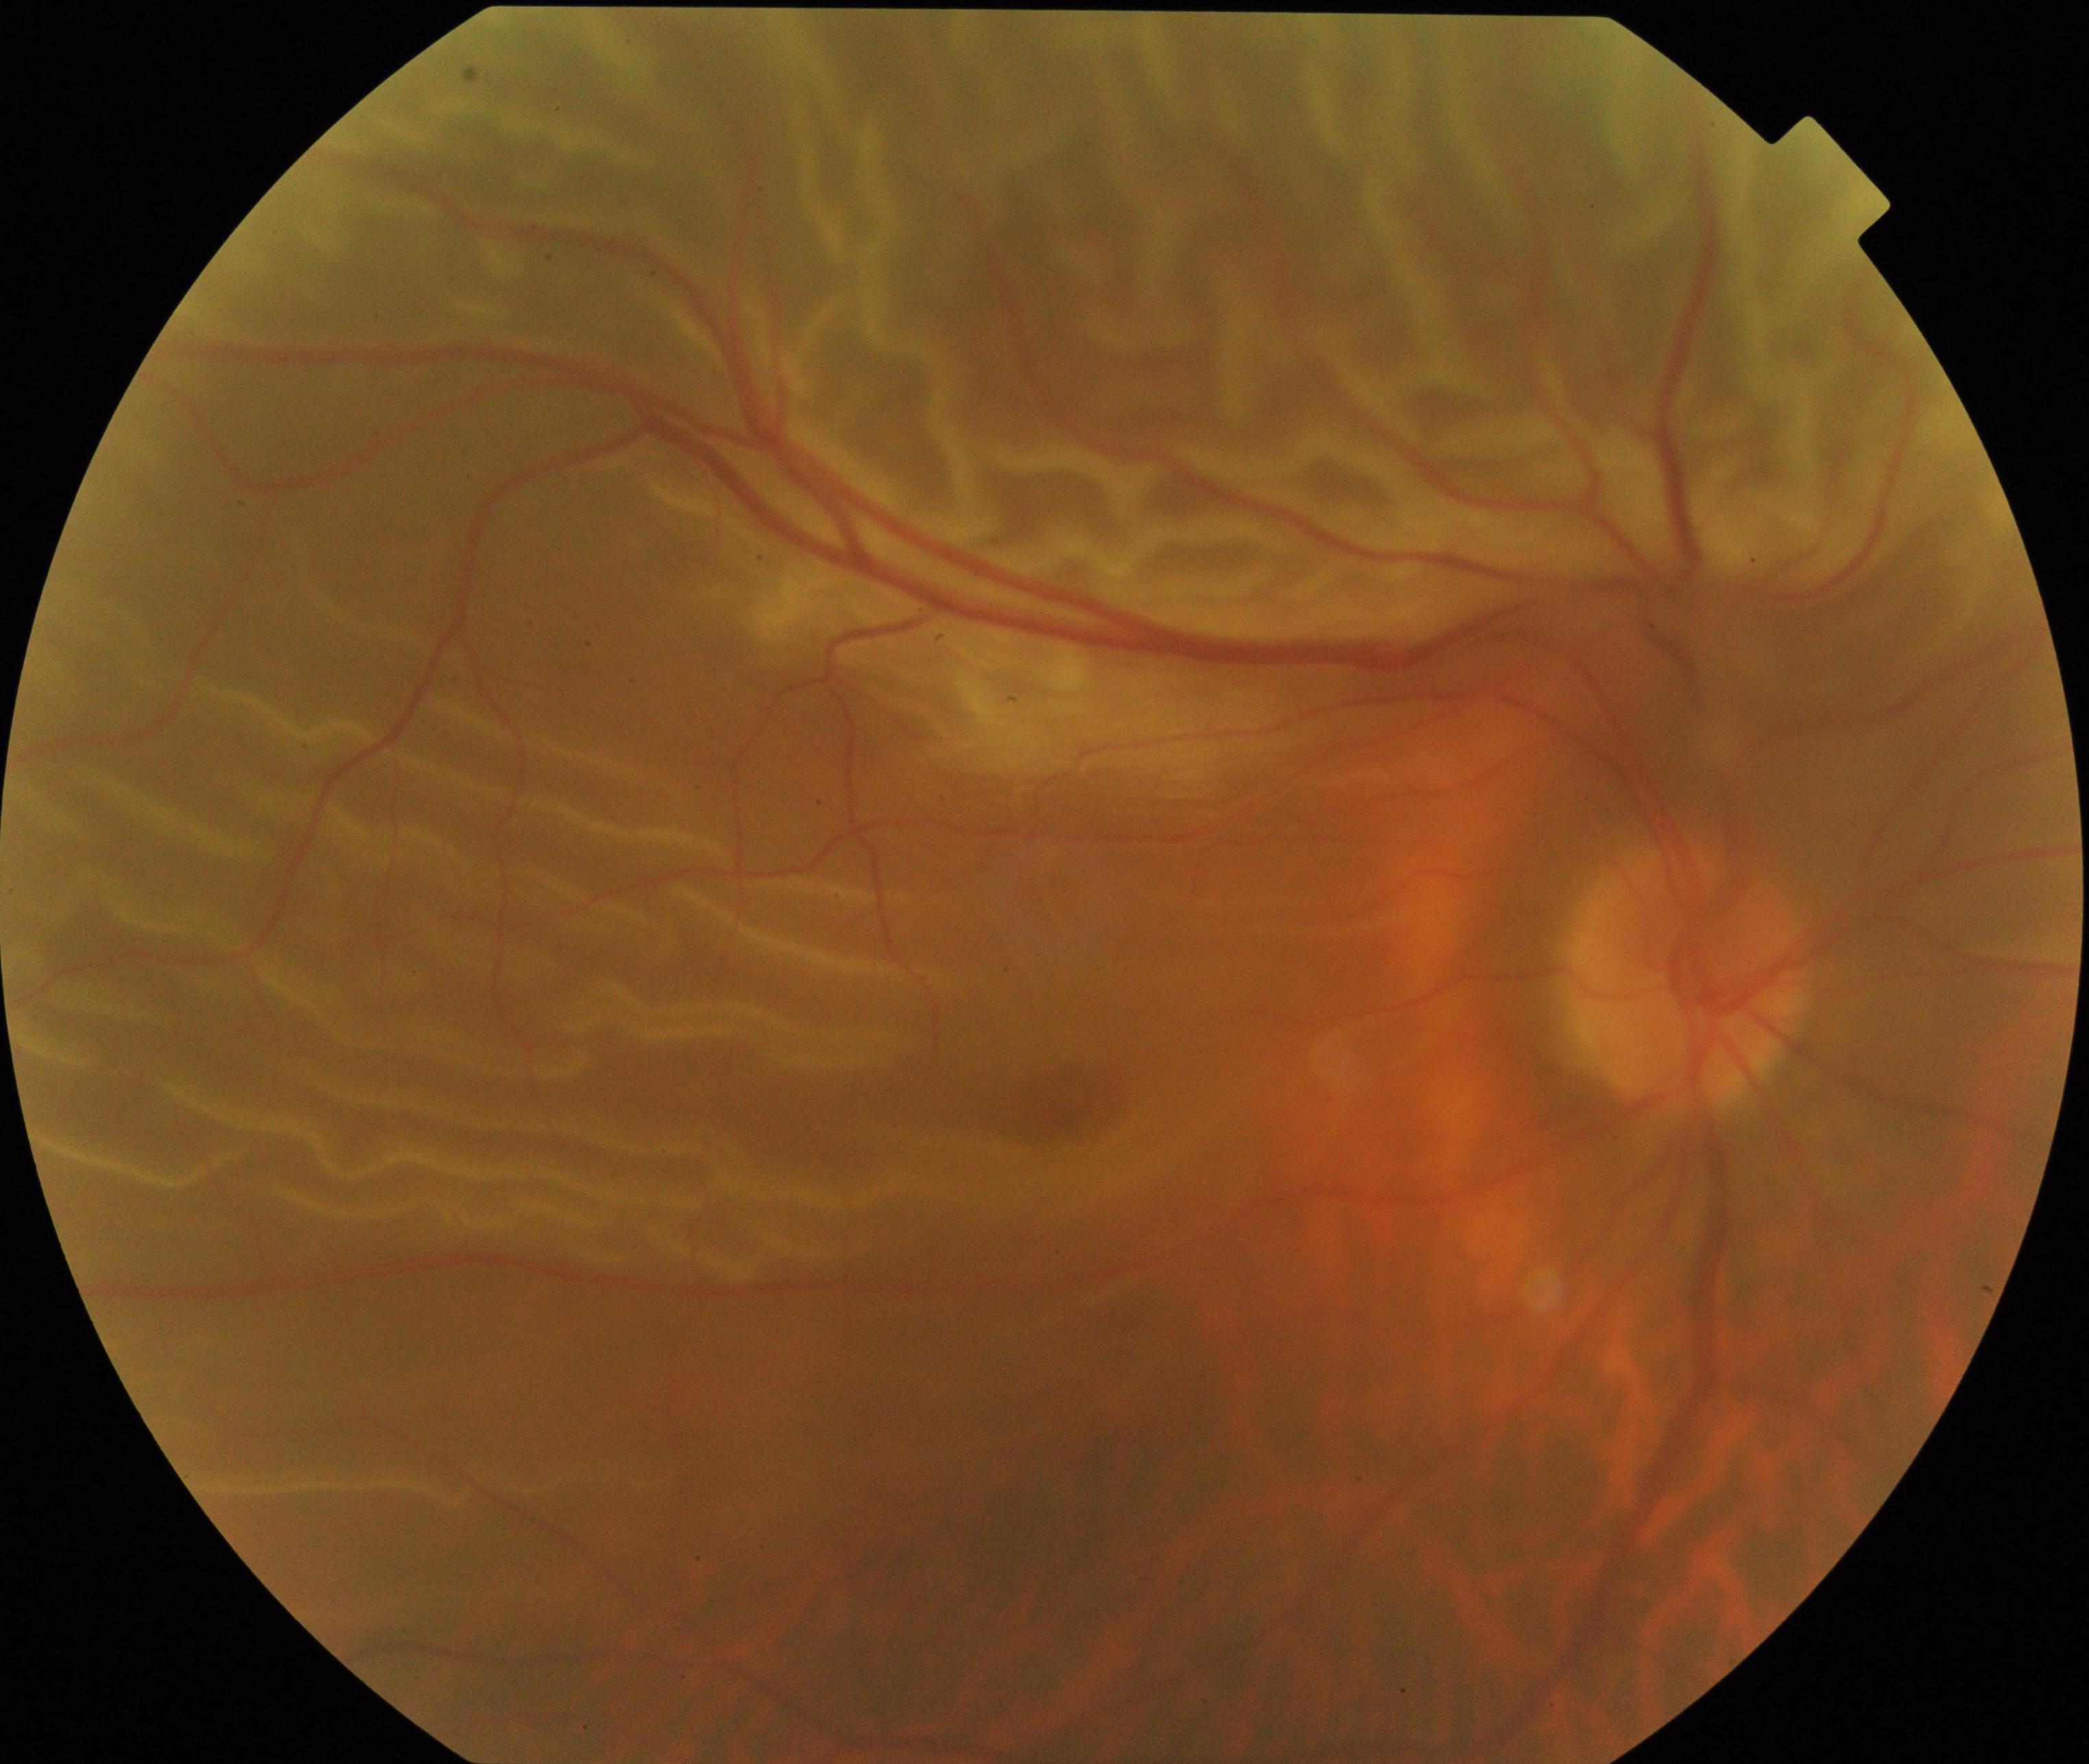
The image shows rhegmatogenous retinal detachment.